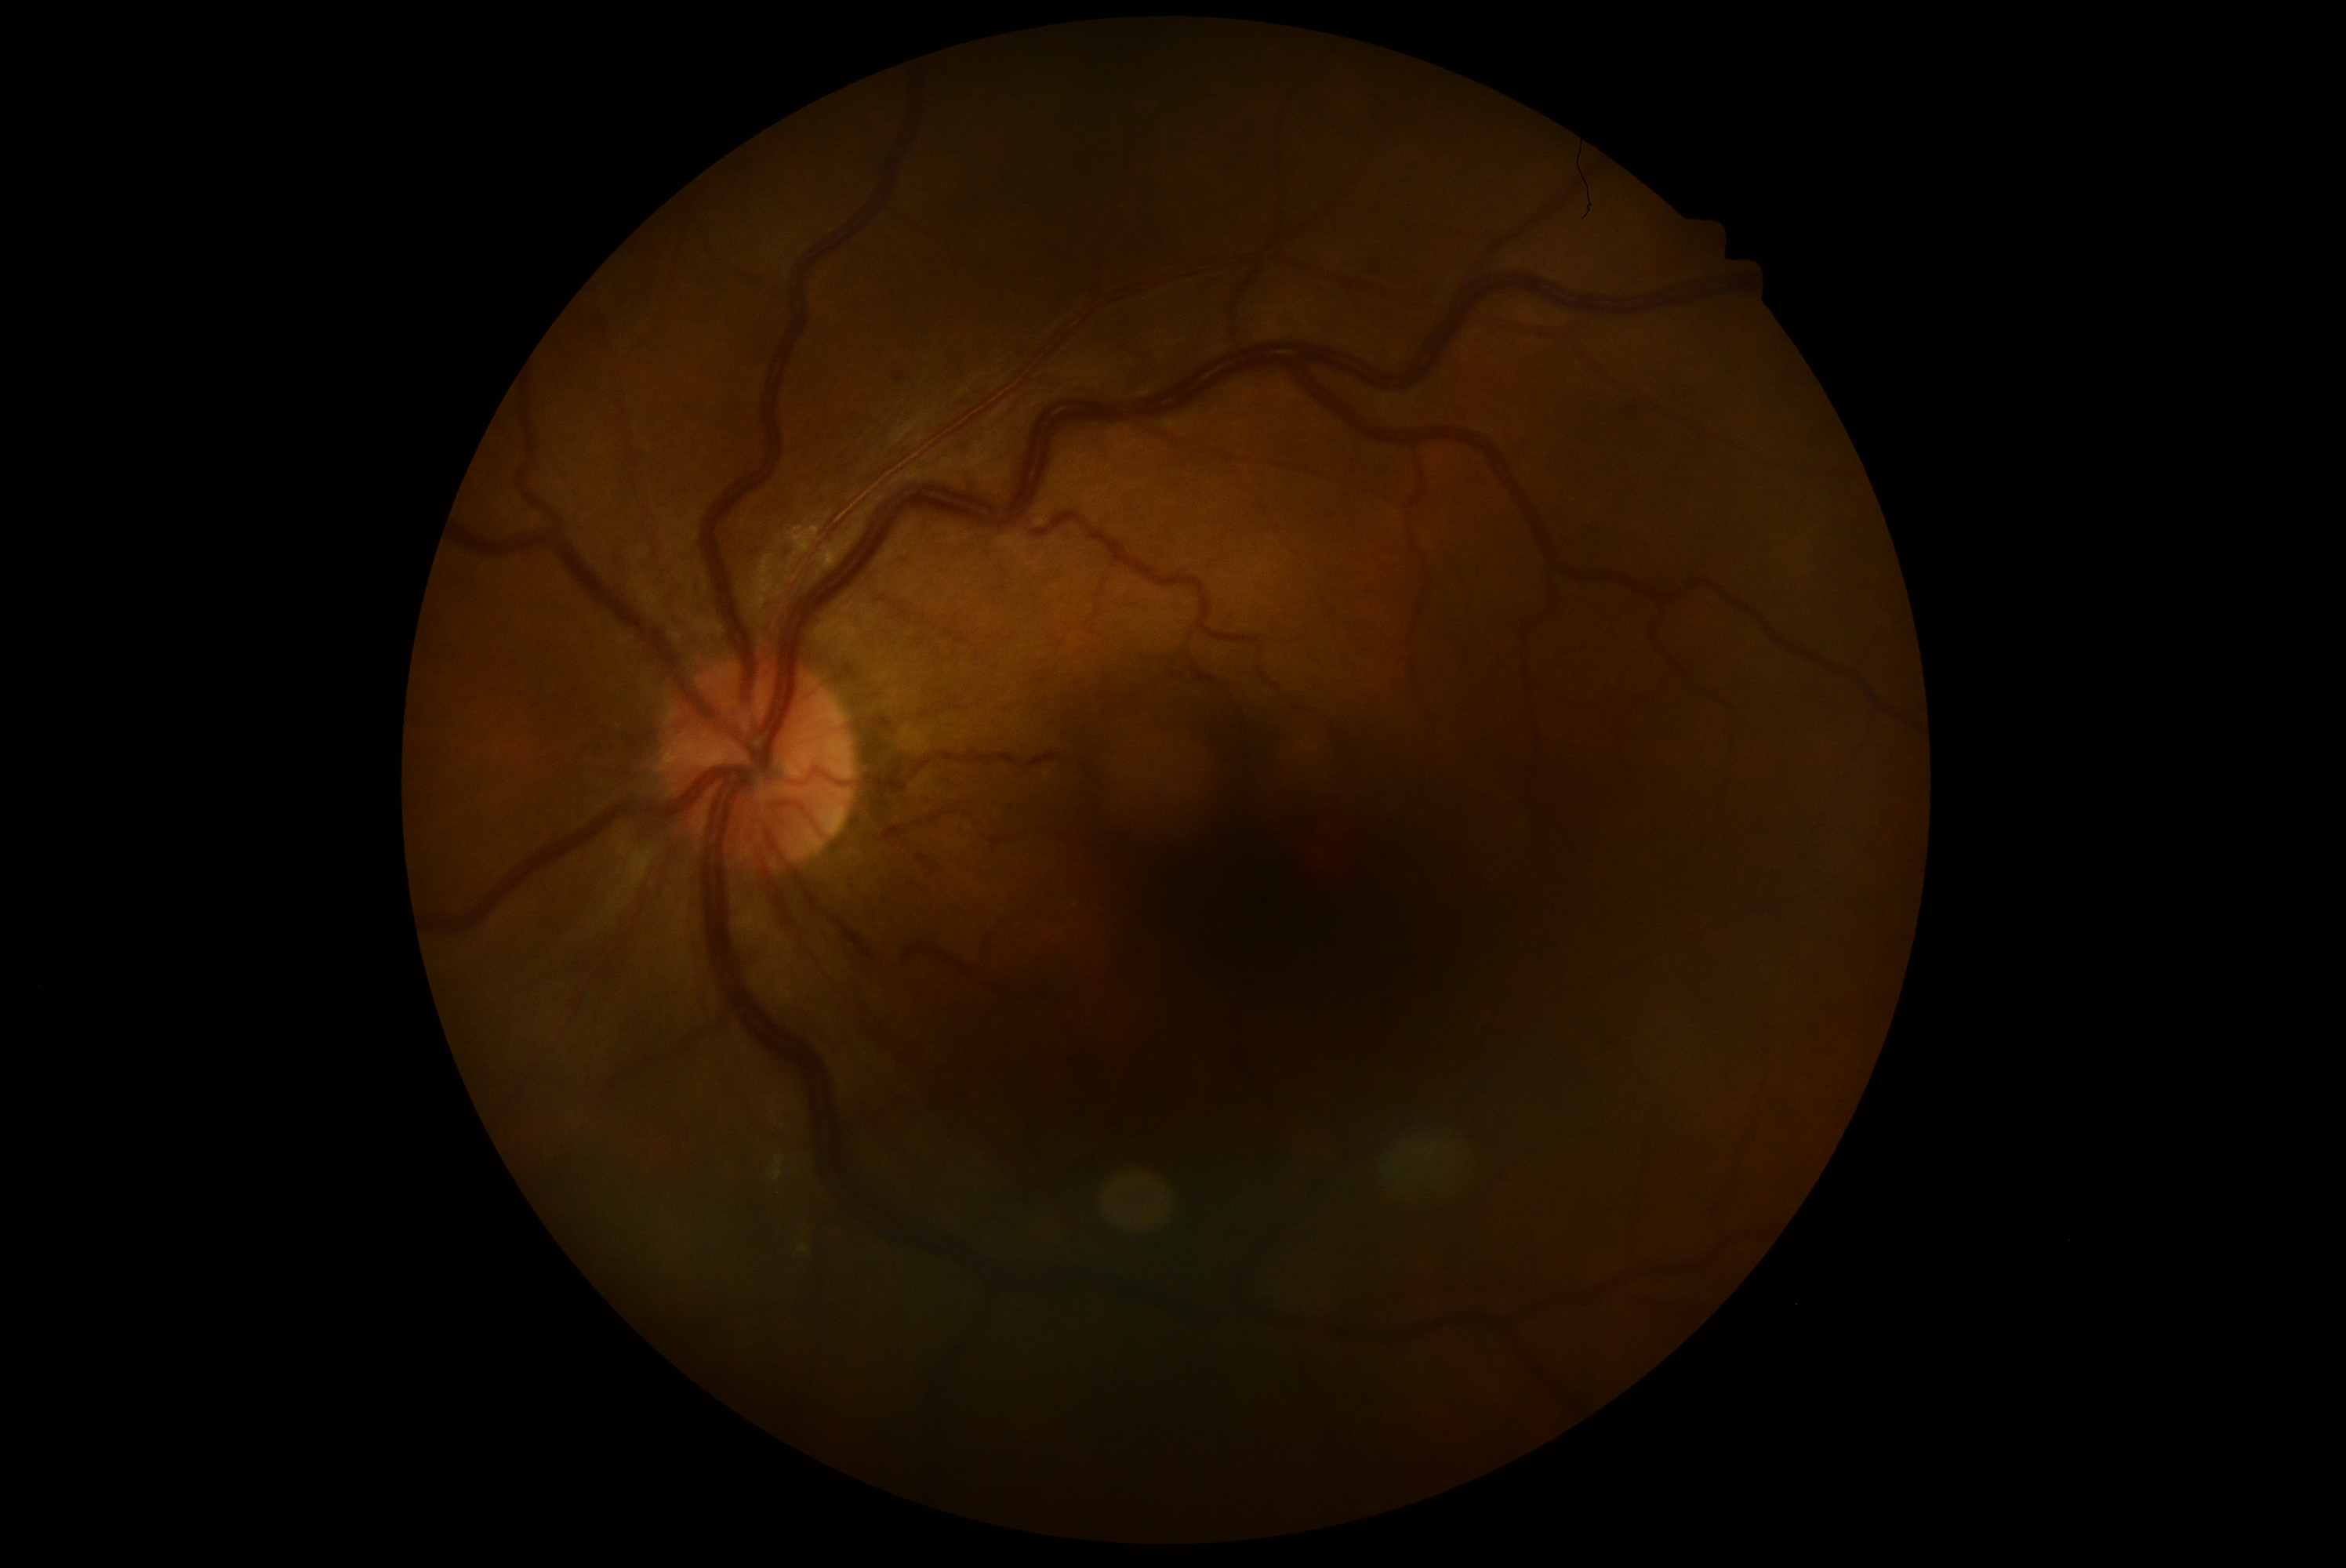 Diabetic retinopathy (DR) is grade 2 (moderate NPDR).